Retinal fundus photograph, 848 by 848 pixels, 45-degree field of view — 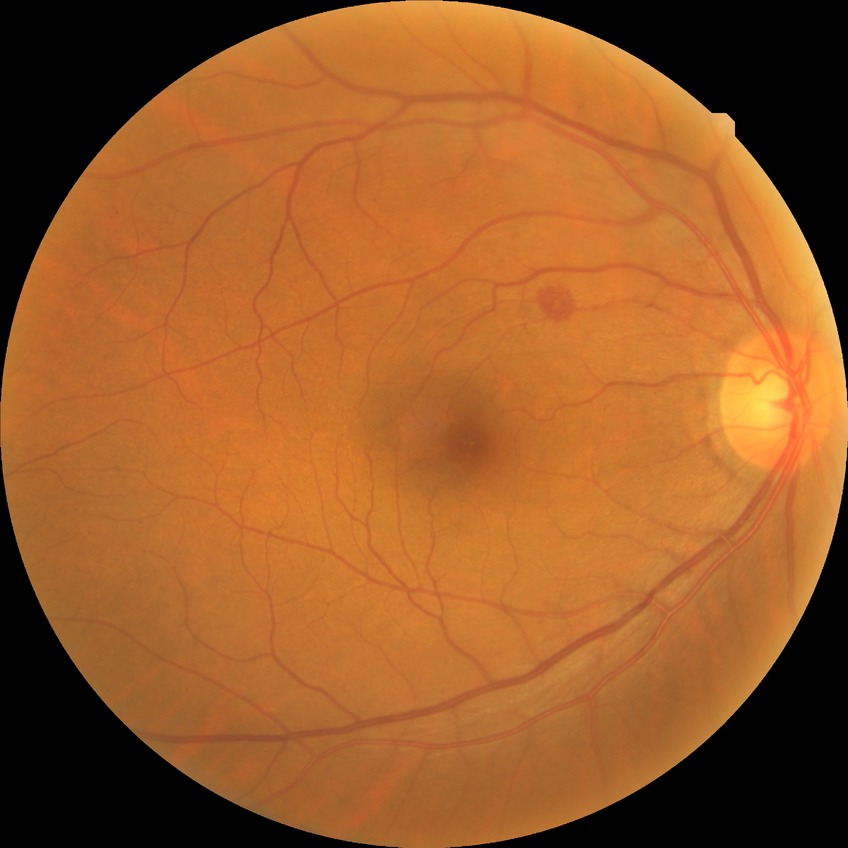

Davis stage is SDR.